Modified Davis grading · CFP.
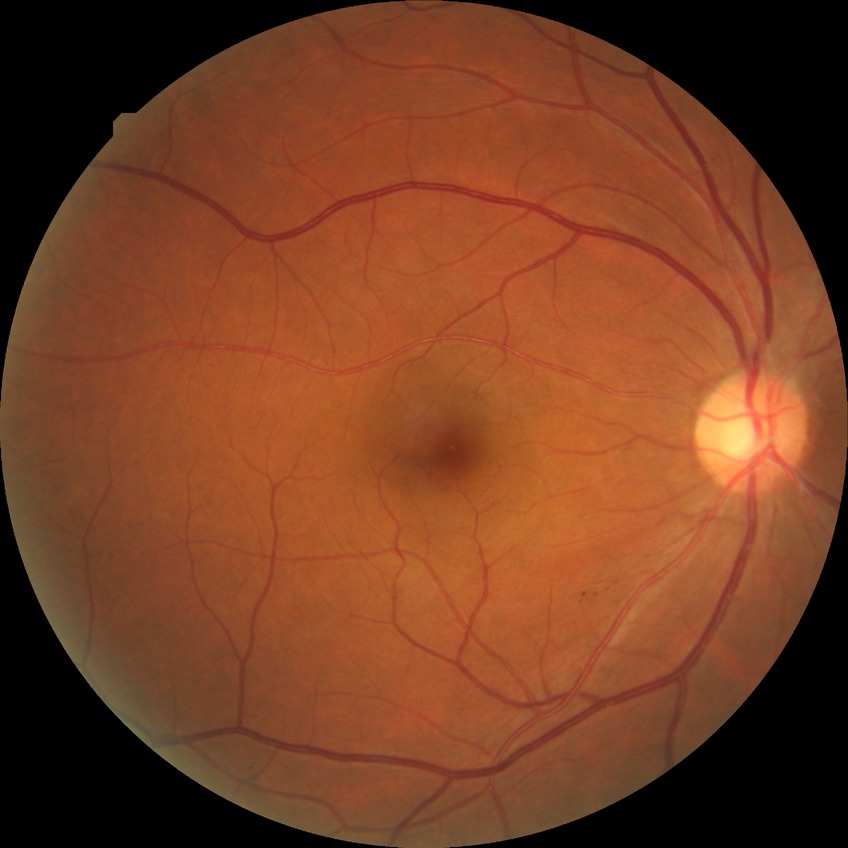
Diabetic retinopathy (DR) is SDR (simple diabetic retinopathy).